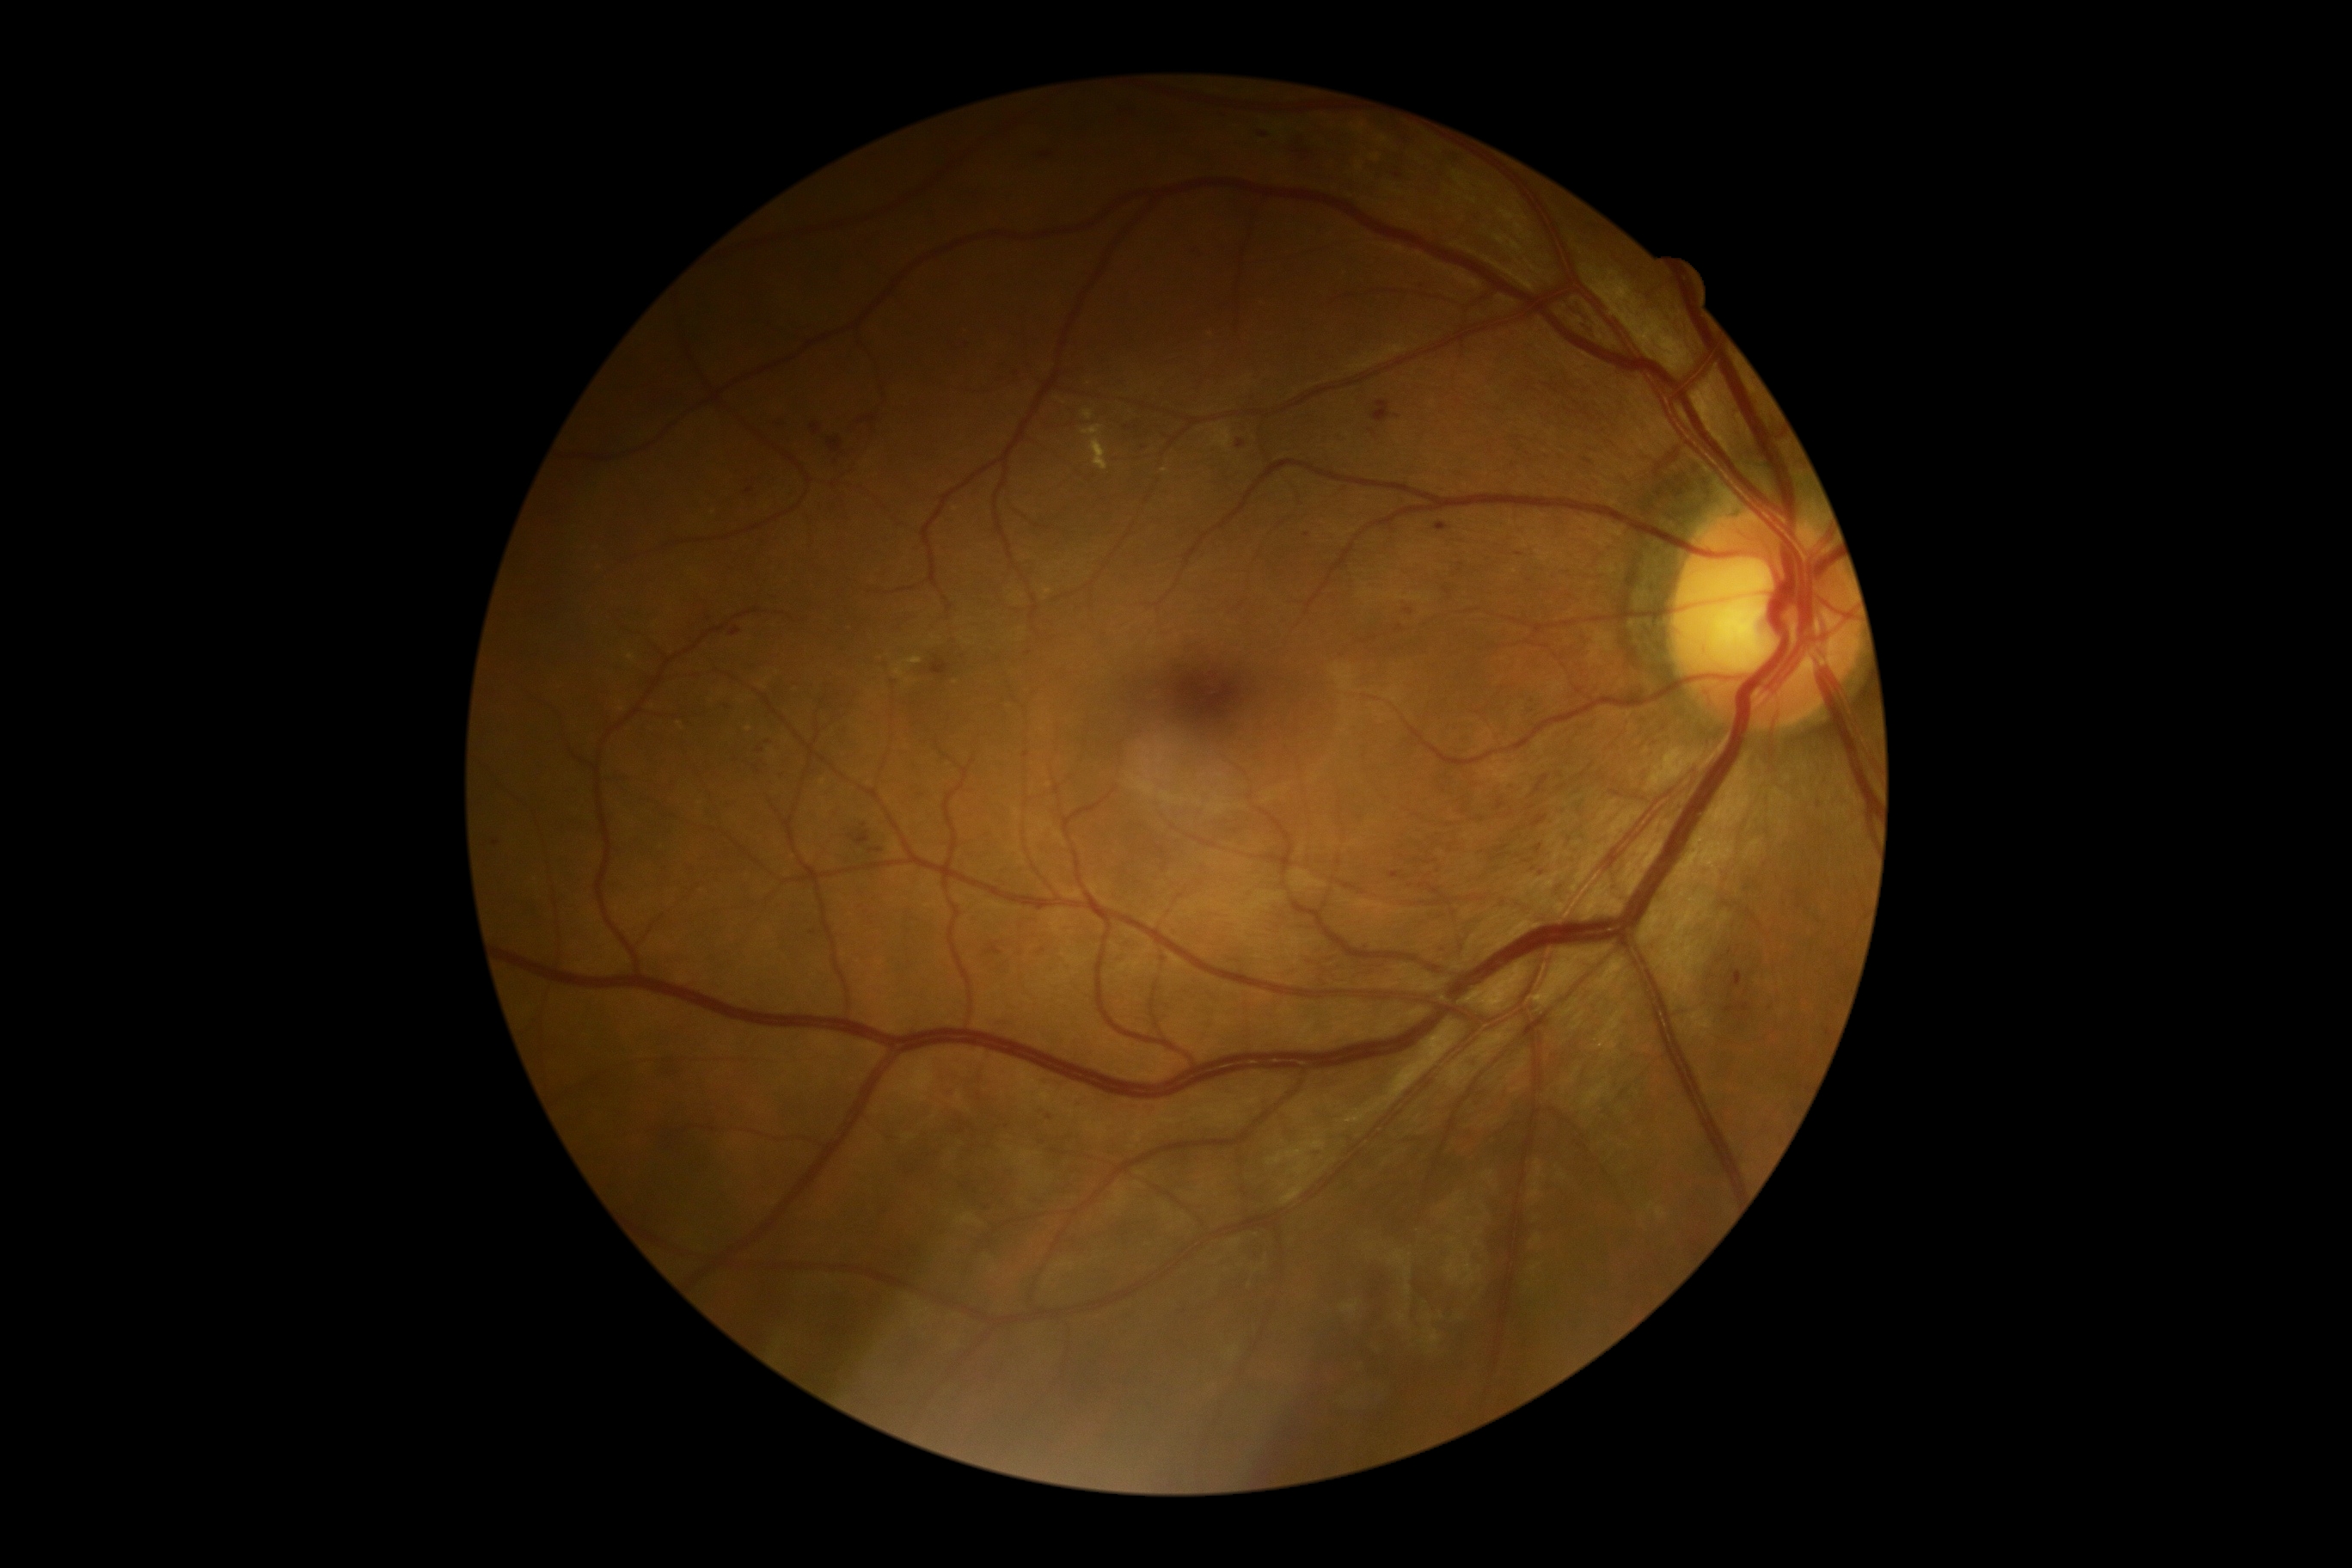

• DR class — non-proliferative diabetic retinopathy
• diabetic retinopathy (DR) — grade 2 (moderate NPDR) — more than just microaneurysms but less than severe NPDR